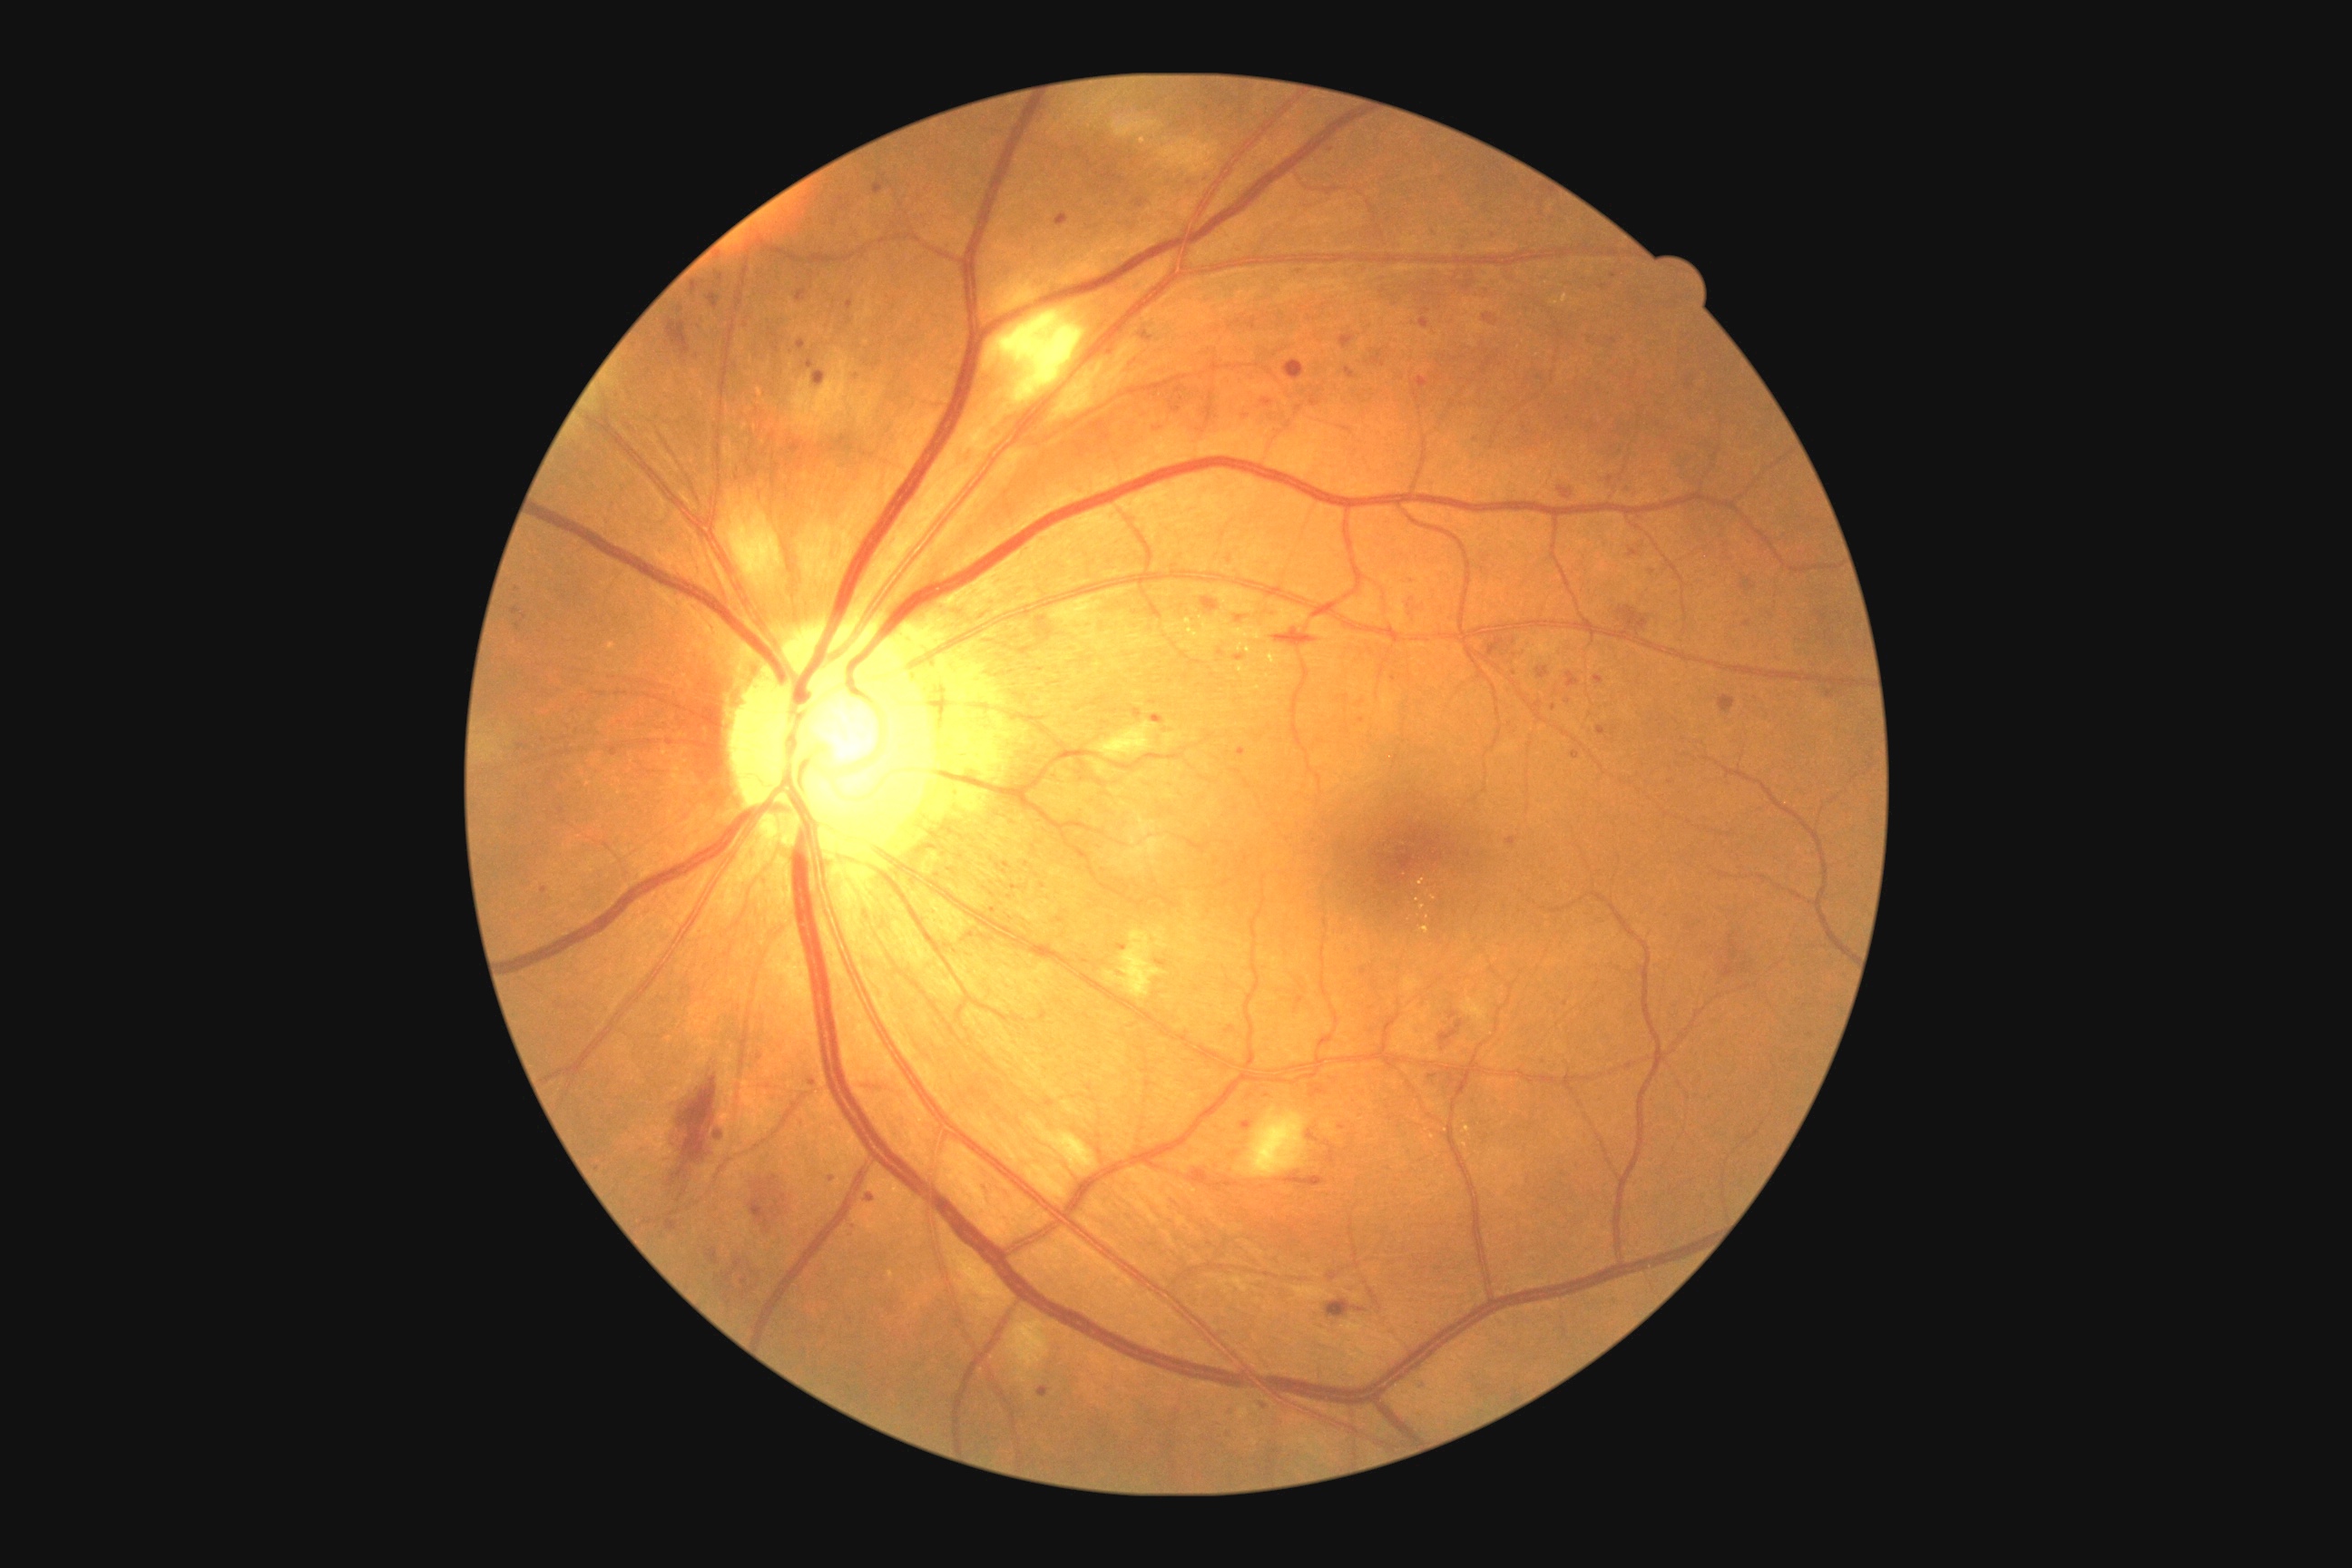

Retinopathy is grade 2 (moderate NPDR)
A subset of detected lesions:
microaneurysms (subset) = (794,289,808,304) | (798,340,807,351) | (1534,701,1544,710) | (1358,718,1366,723) | (1353,1308,1367,1313) | (1571,752,1580,760) | (709,291,720,309) | (1055,213,1068,226) | (1141,333,1153,340) | (1404,596,1426,622) | (1106,342,1115,357) | (1248,318,1257,331)
Smaller microaneurysms around (1653, 573) | (1060, 920) | (1247, 416) | (1476, 440) | (521, 747) | (1554, 707) | (1154, 702) | (1220, 654)